Infant wide-field fundus photograph; 640 by 480 pixels — 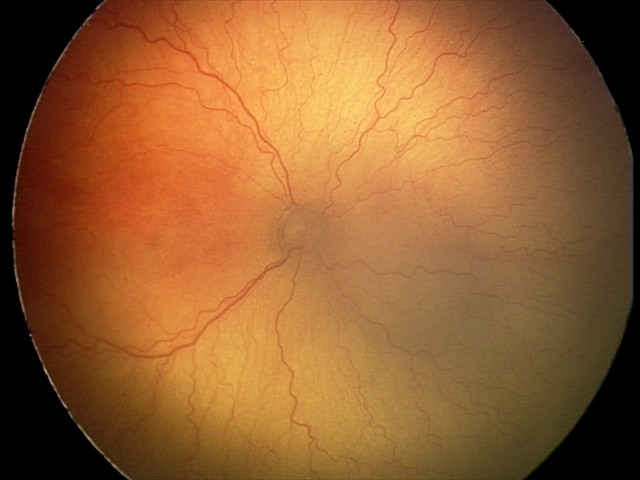 Plus disease was diagnosed. Examination diagnosed as aggressive retinopathy of prematurity.